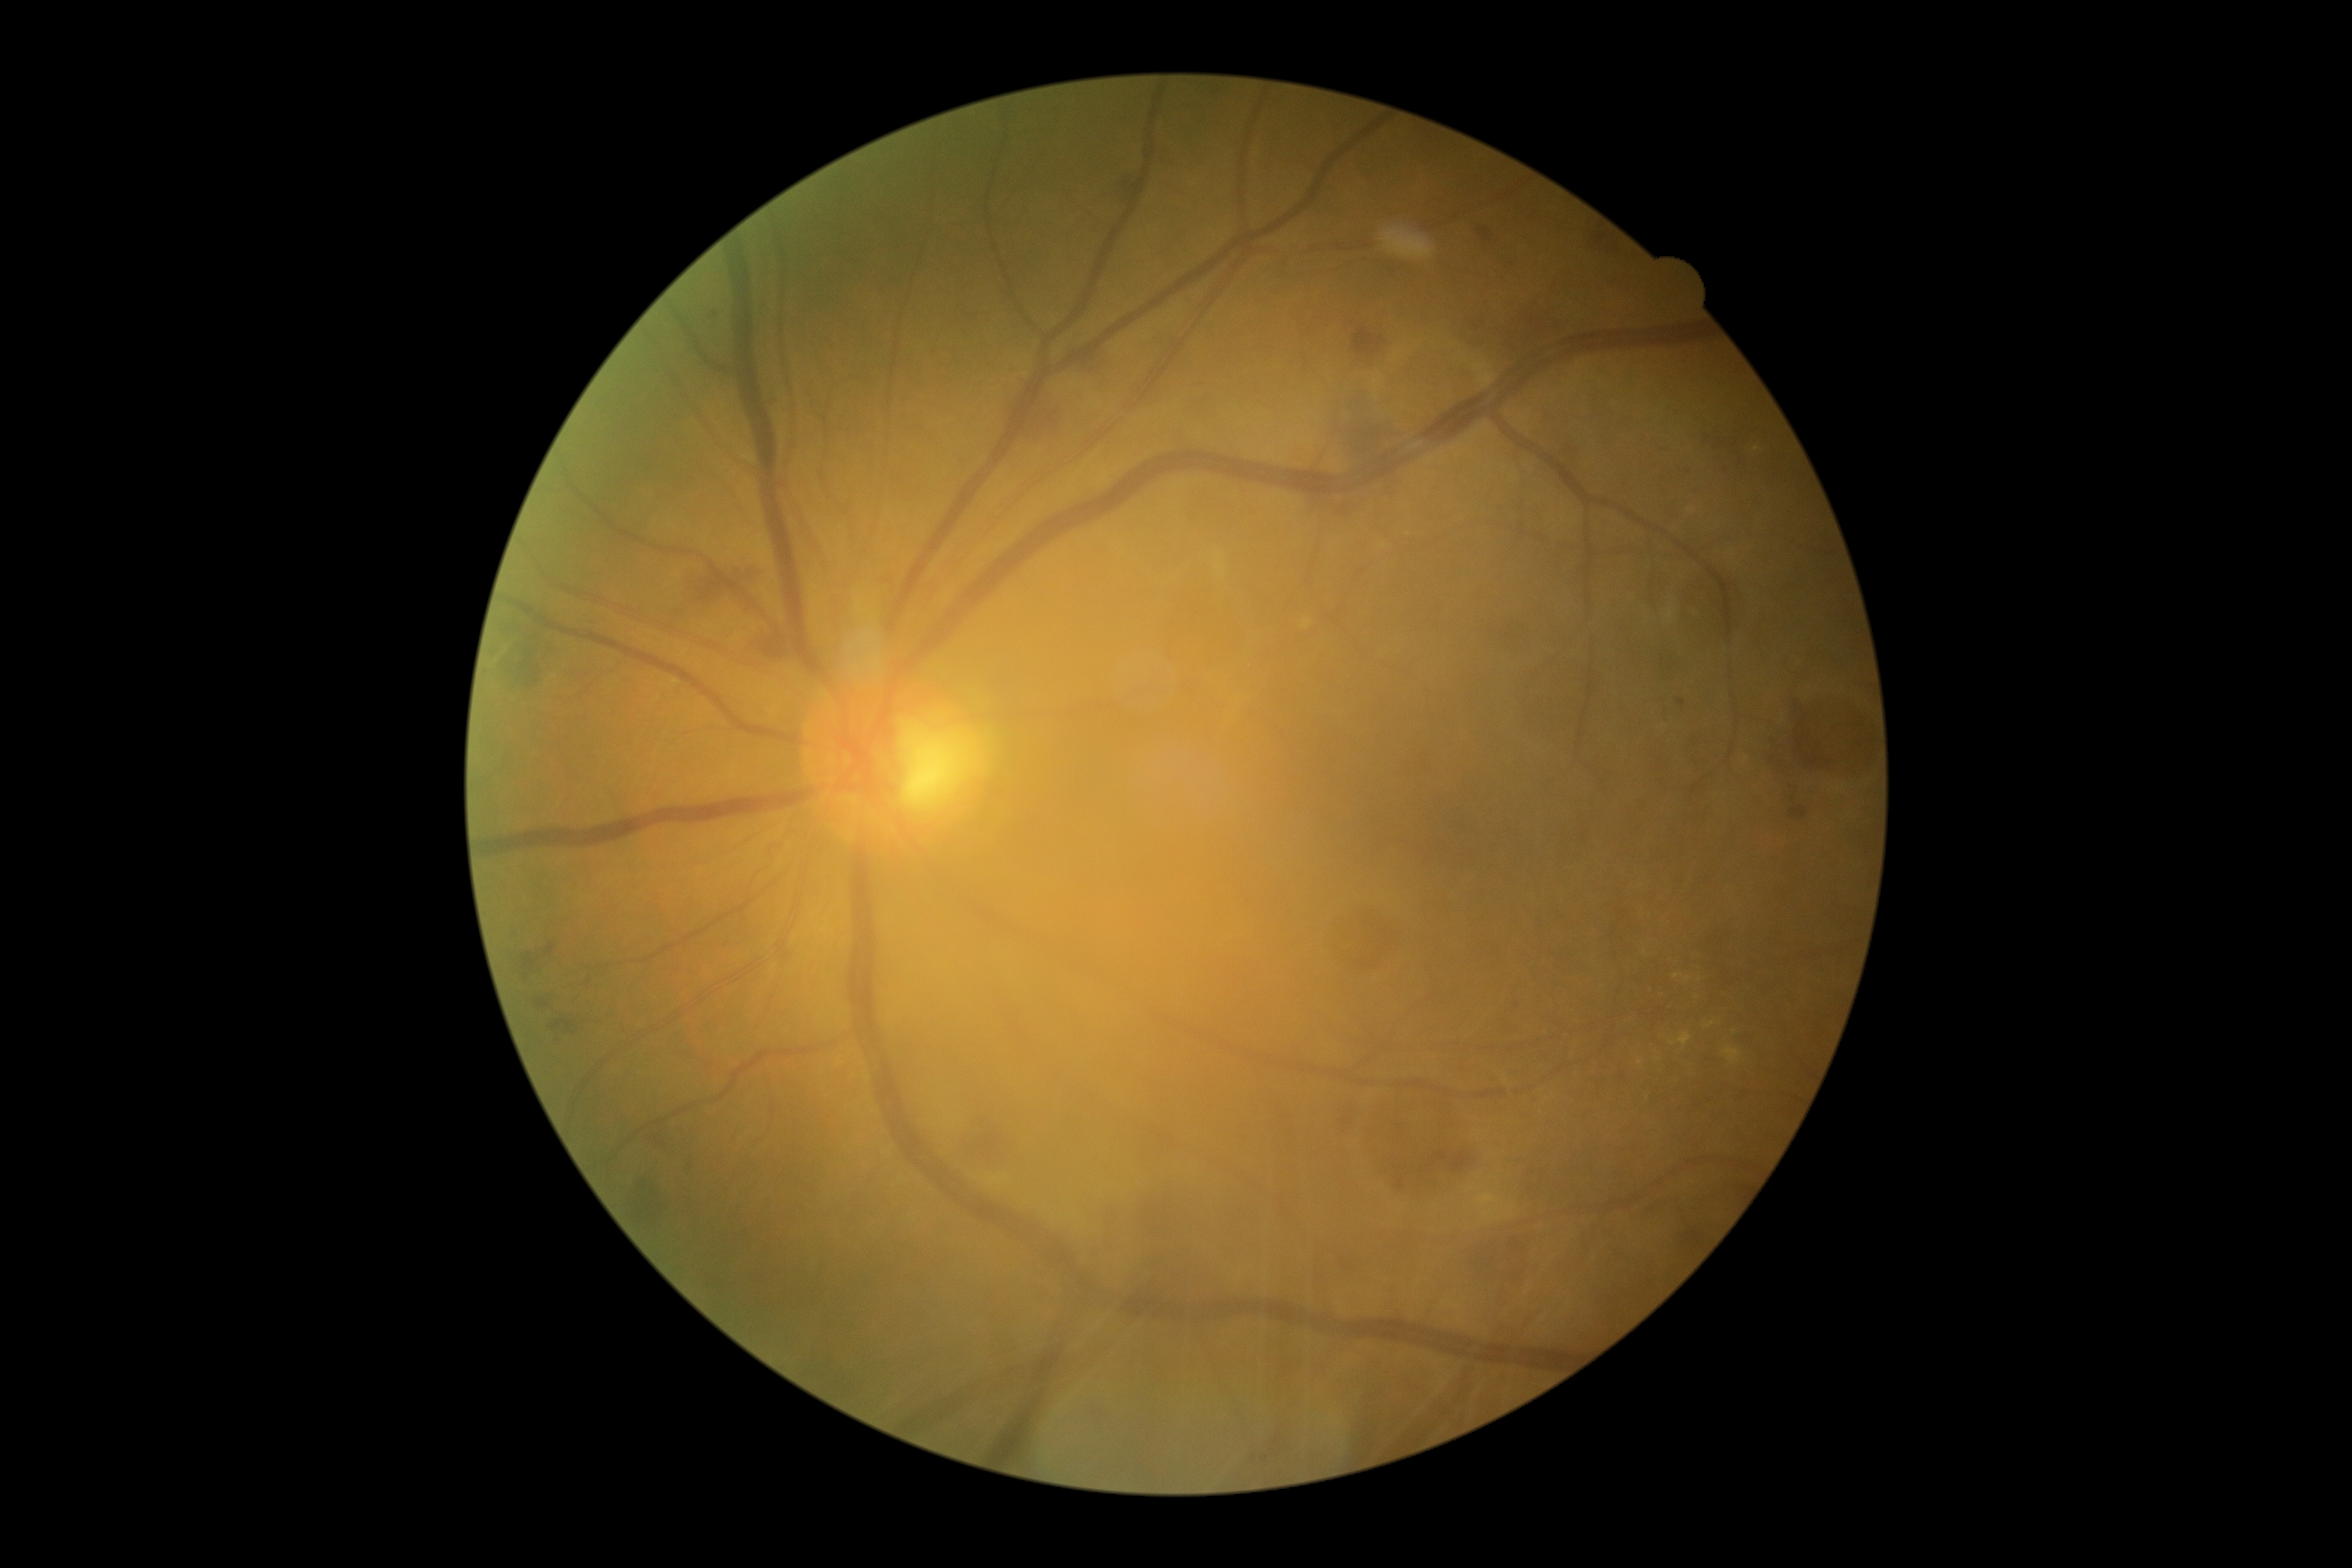

Diabetic retinopathy (DR) is 2
Selected lesions:
hemorrhages (HEs) (more not shown): 690, 561, 754, 611; 549, 1015, 587, 1036; 1120, 178, 1134, 204; 517, 634, 556, 690; 1351, 319, 1388, 364; 1478, 228, 1495, 245; 1321, 491, 1371, 520; 1765, 749, 1808, 826; 974, 1127, 1007, 1163; 1082, 353, 1101, 374
Small HEs near <pt>513,672</pt>; <pt>559,1041</pt>
microaneurysms (MAs): 709, 314, 718, 319; 1675, 697, 1687, 709; 1342, 1256, 1357, 1273
soft exudates (SEs): none identified
hard exudates (EXs): 1724, 1048, 1743, 1067; 1669, 1032, 1693, 1046; 1674, 974, 1691, 983
Small EXs near <pt>1711,1024</pt>; <pt>1641,1061</pt>